Wide-field fundus image from infant ROP screening: 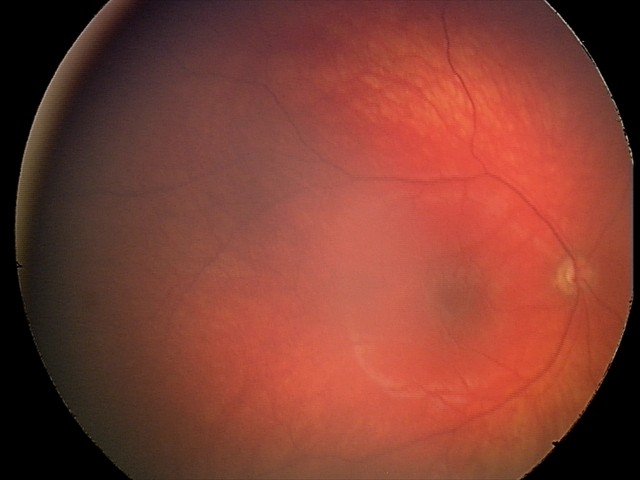
Screening examination consistent with optic nerve hypoplasia.